2352x1568px
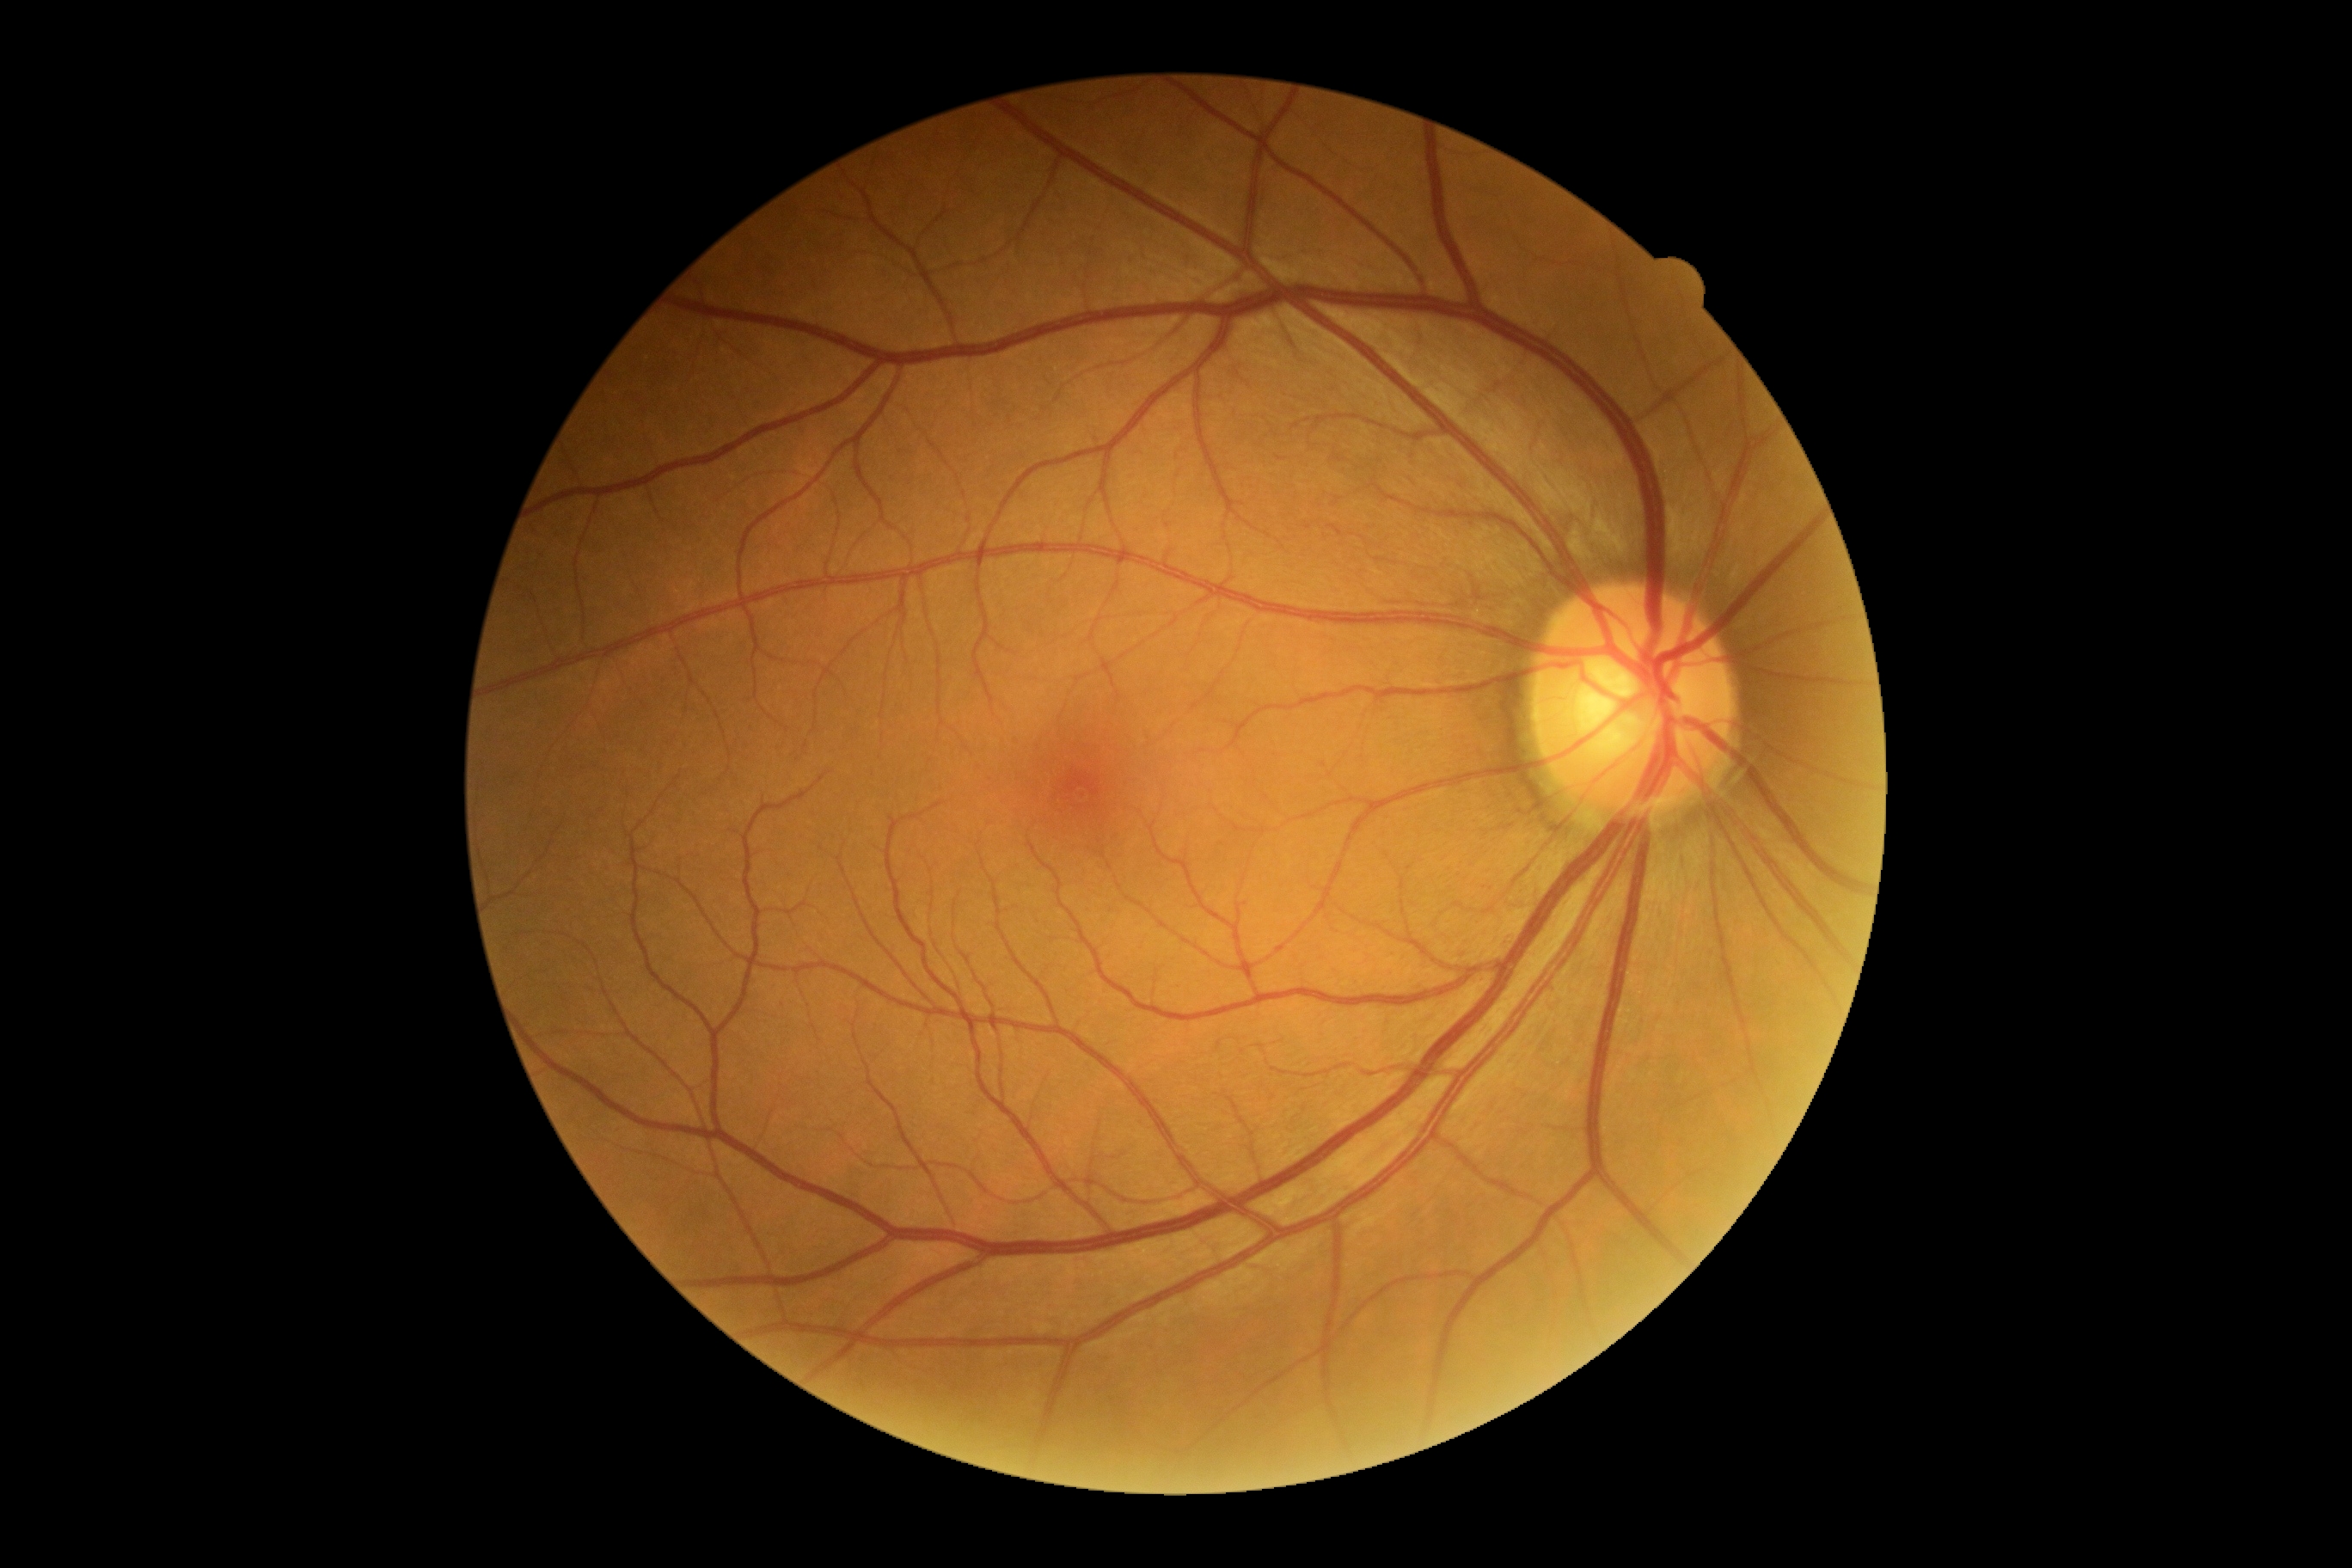
Findings:
• diabetic retinopathy severity — no apparent retinopathy (grade 0)